Tabletop color fundus camera image · FOV: 50 degrees · 1924x1556 — 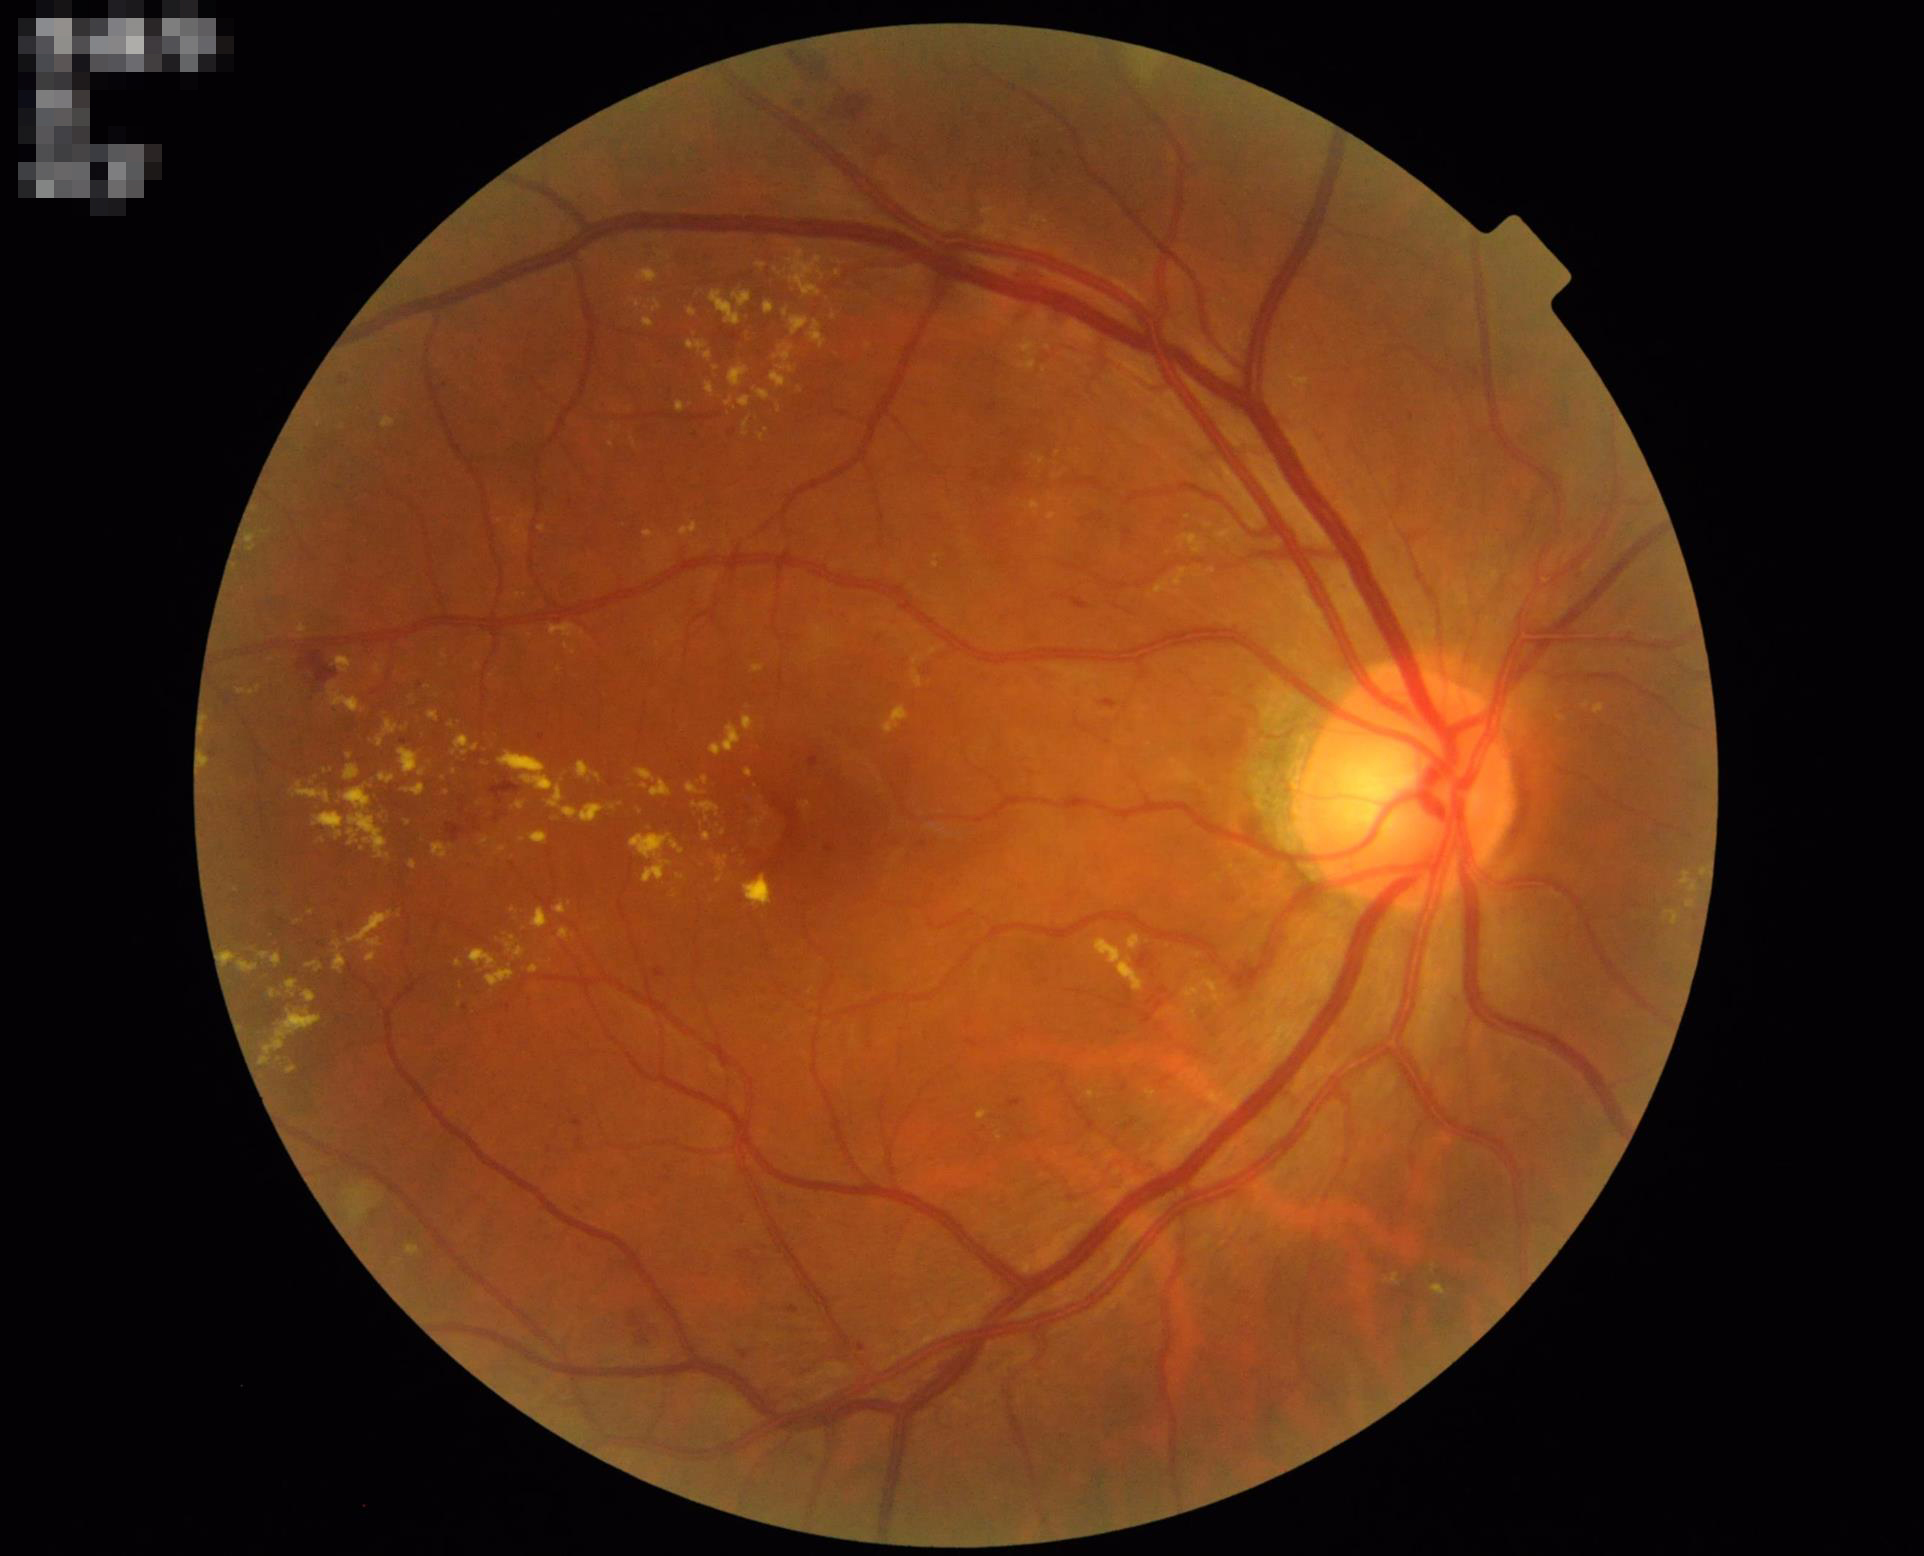

Quality assessment:
- contrast: adequate
- illumination: even
- focus: in focus
- overall: adequate